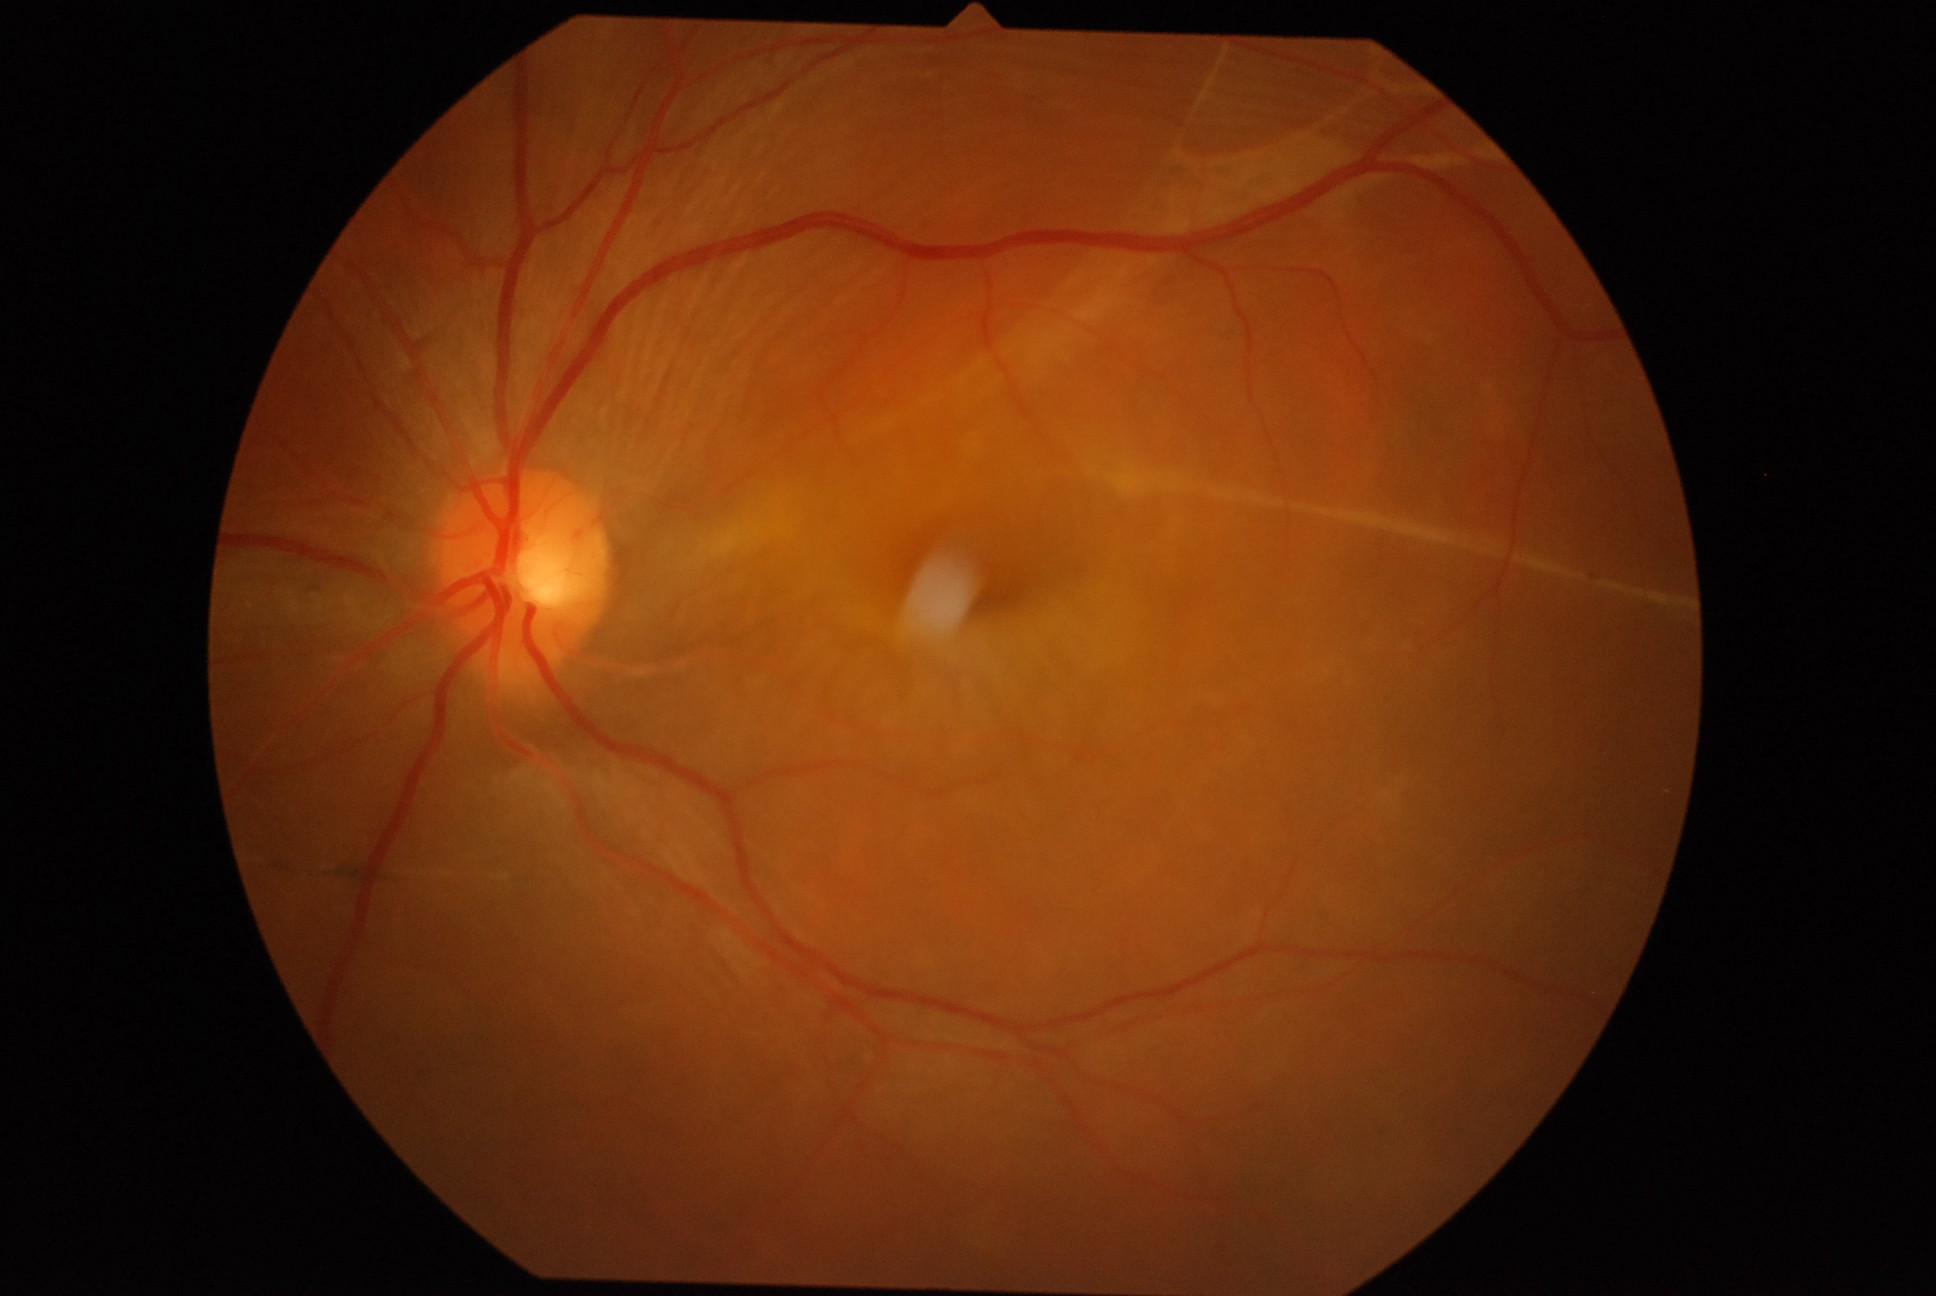 Findings:
– retinopathy — 4/4